Infant wide-field fundus photograph · Clarity RetCam 3, 130° FOV:
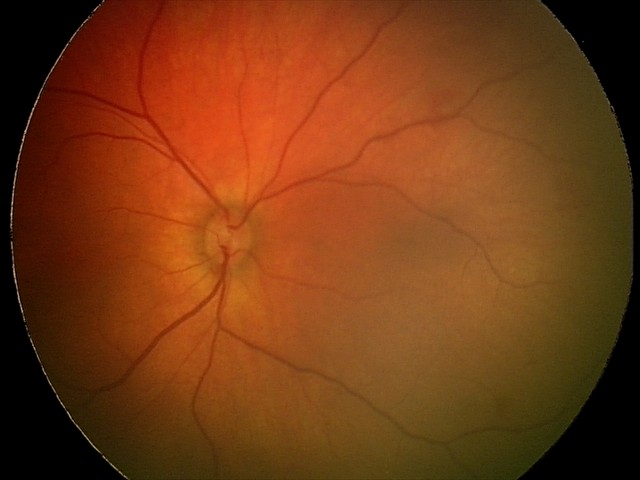

Series diagnosed as retinal hemorrhages.